NIDEK AFC-230
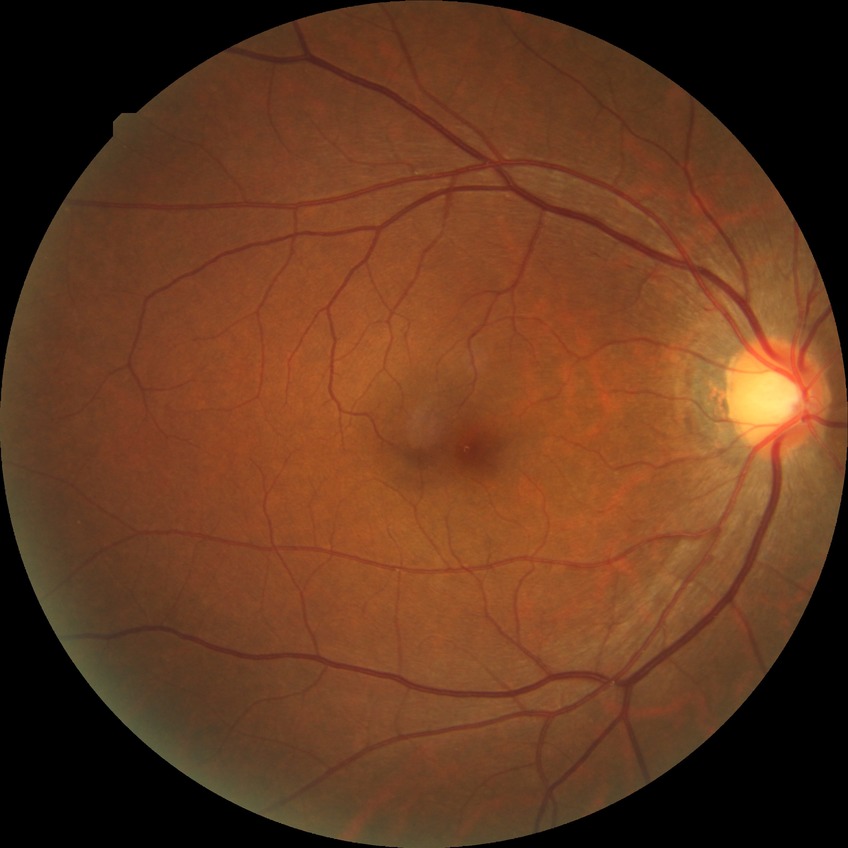
Diabetic retinopathy (DR): no diabetic retinopathy (NDR).